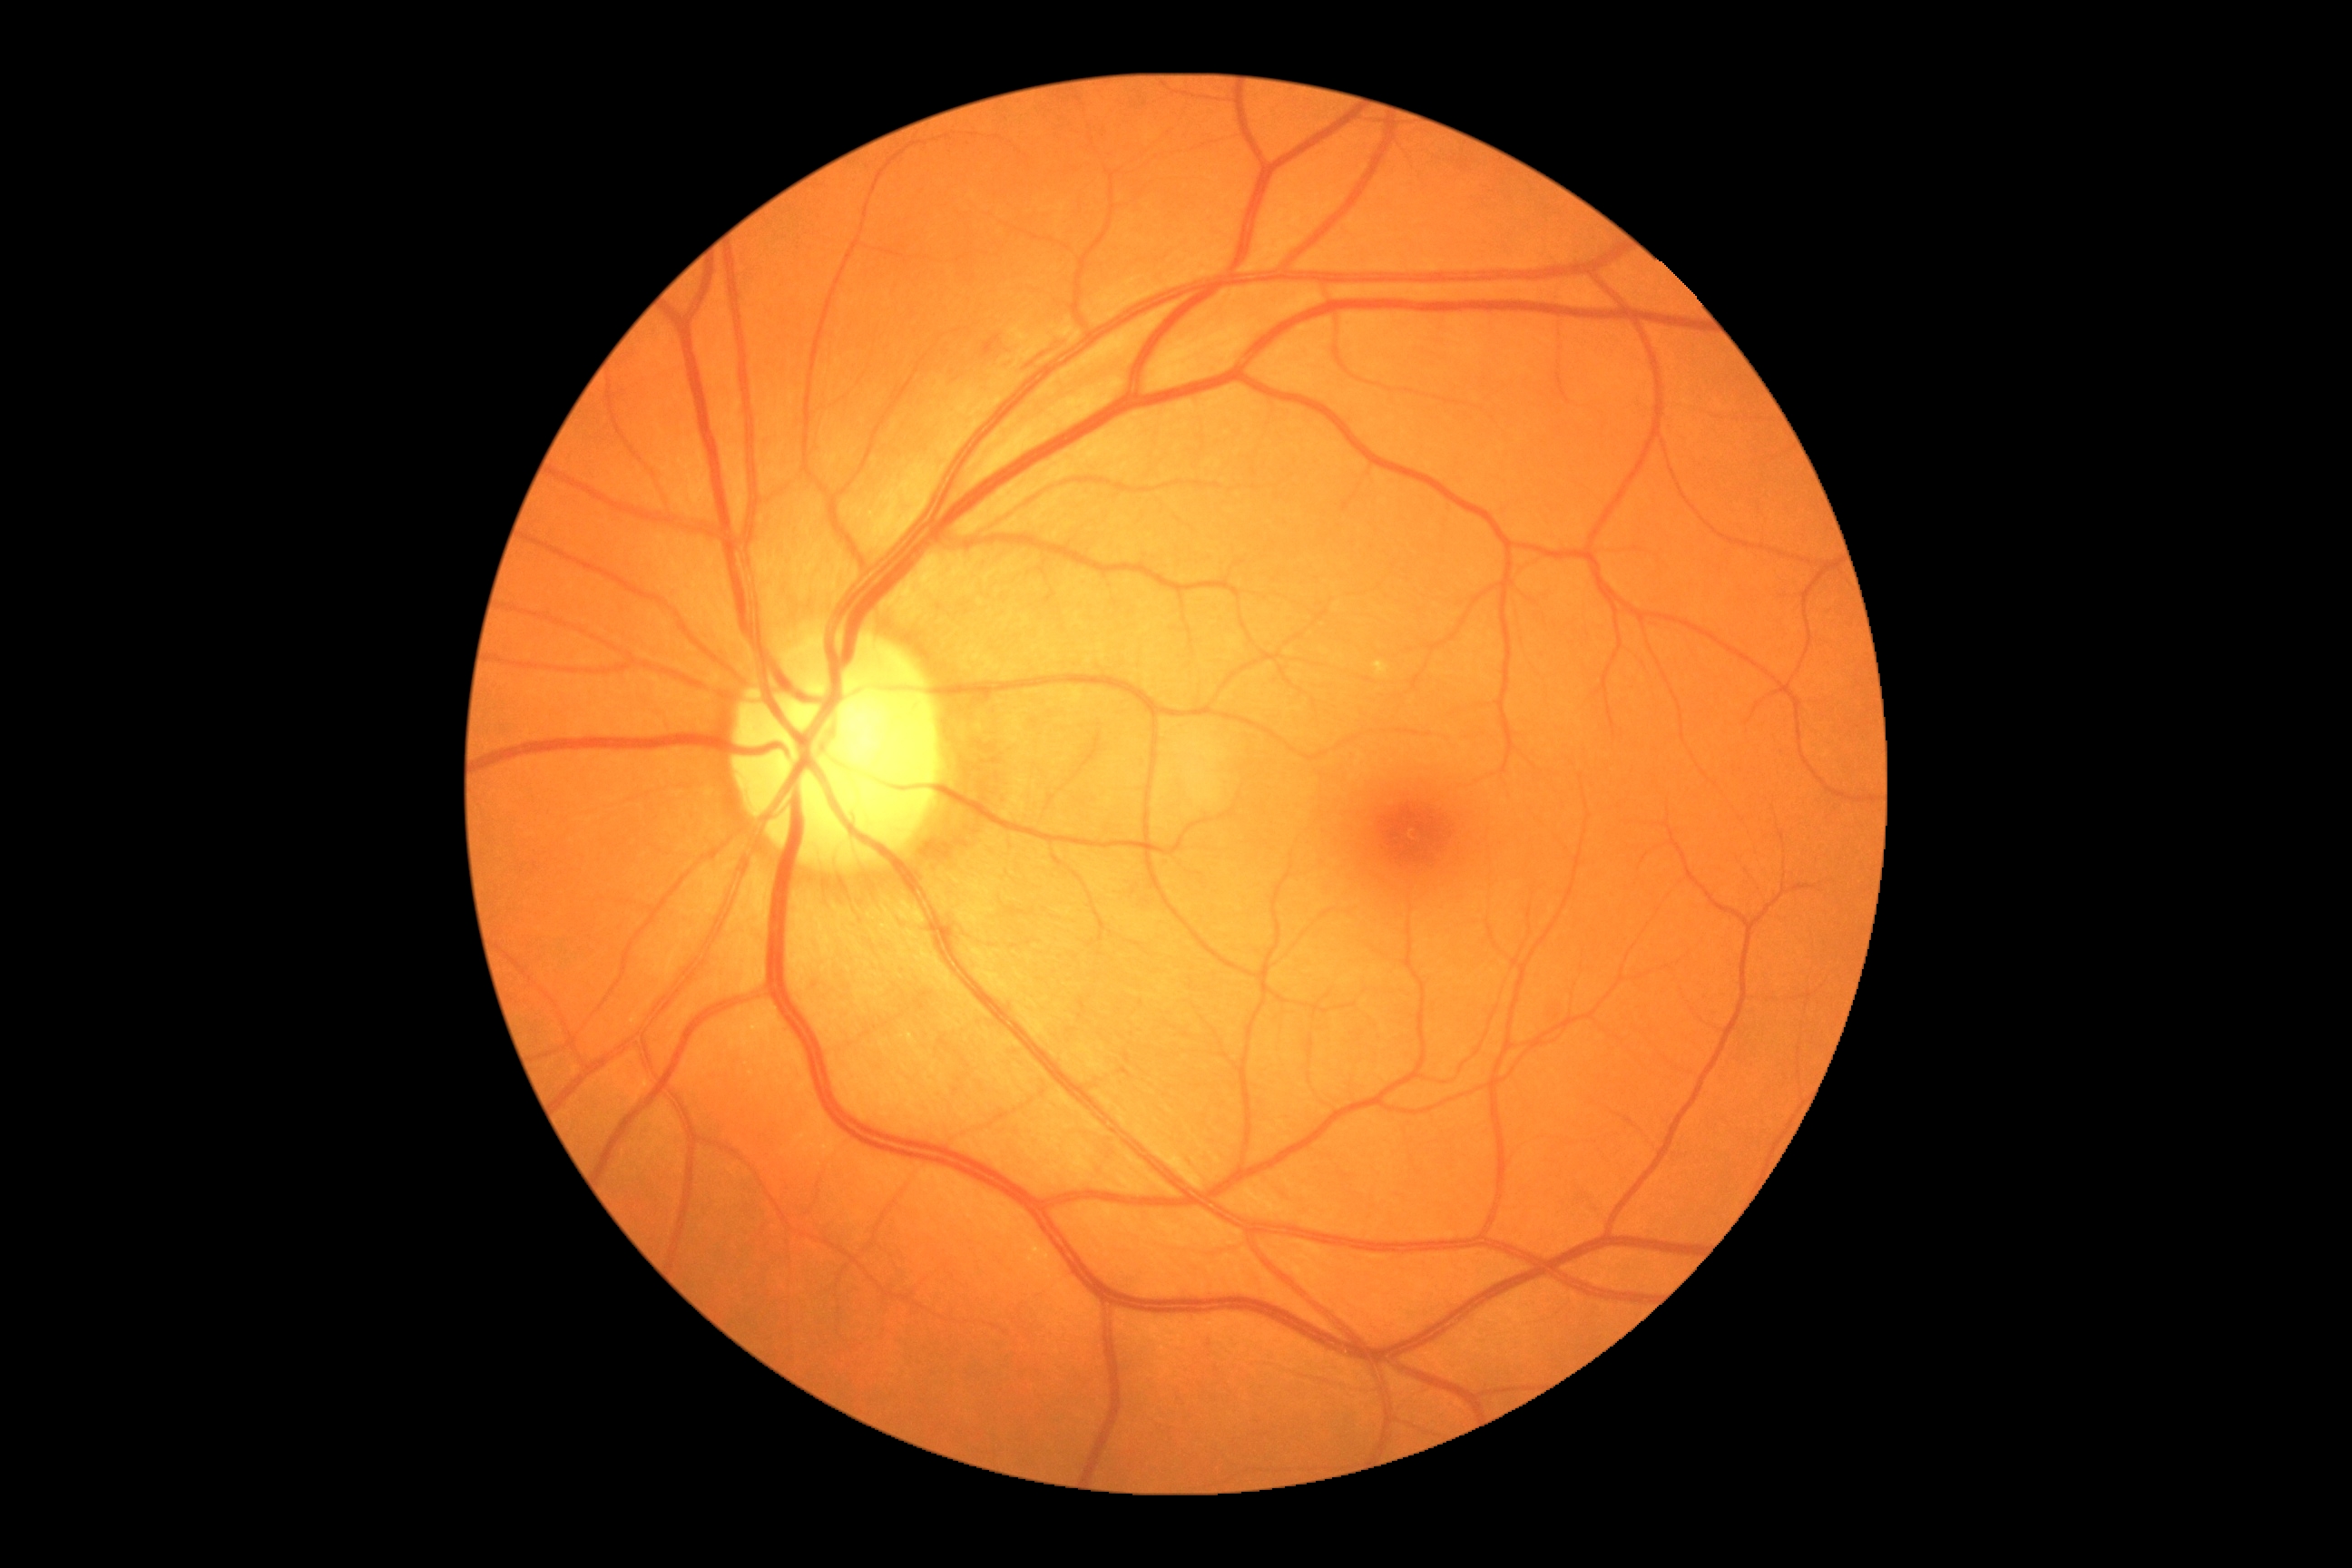 DR severity: moderate NPDR (grade 2).